Fundus photo · 1659 by 2212 pixels
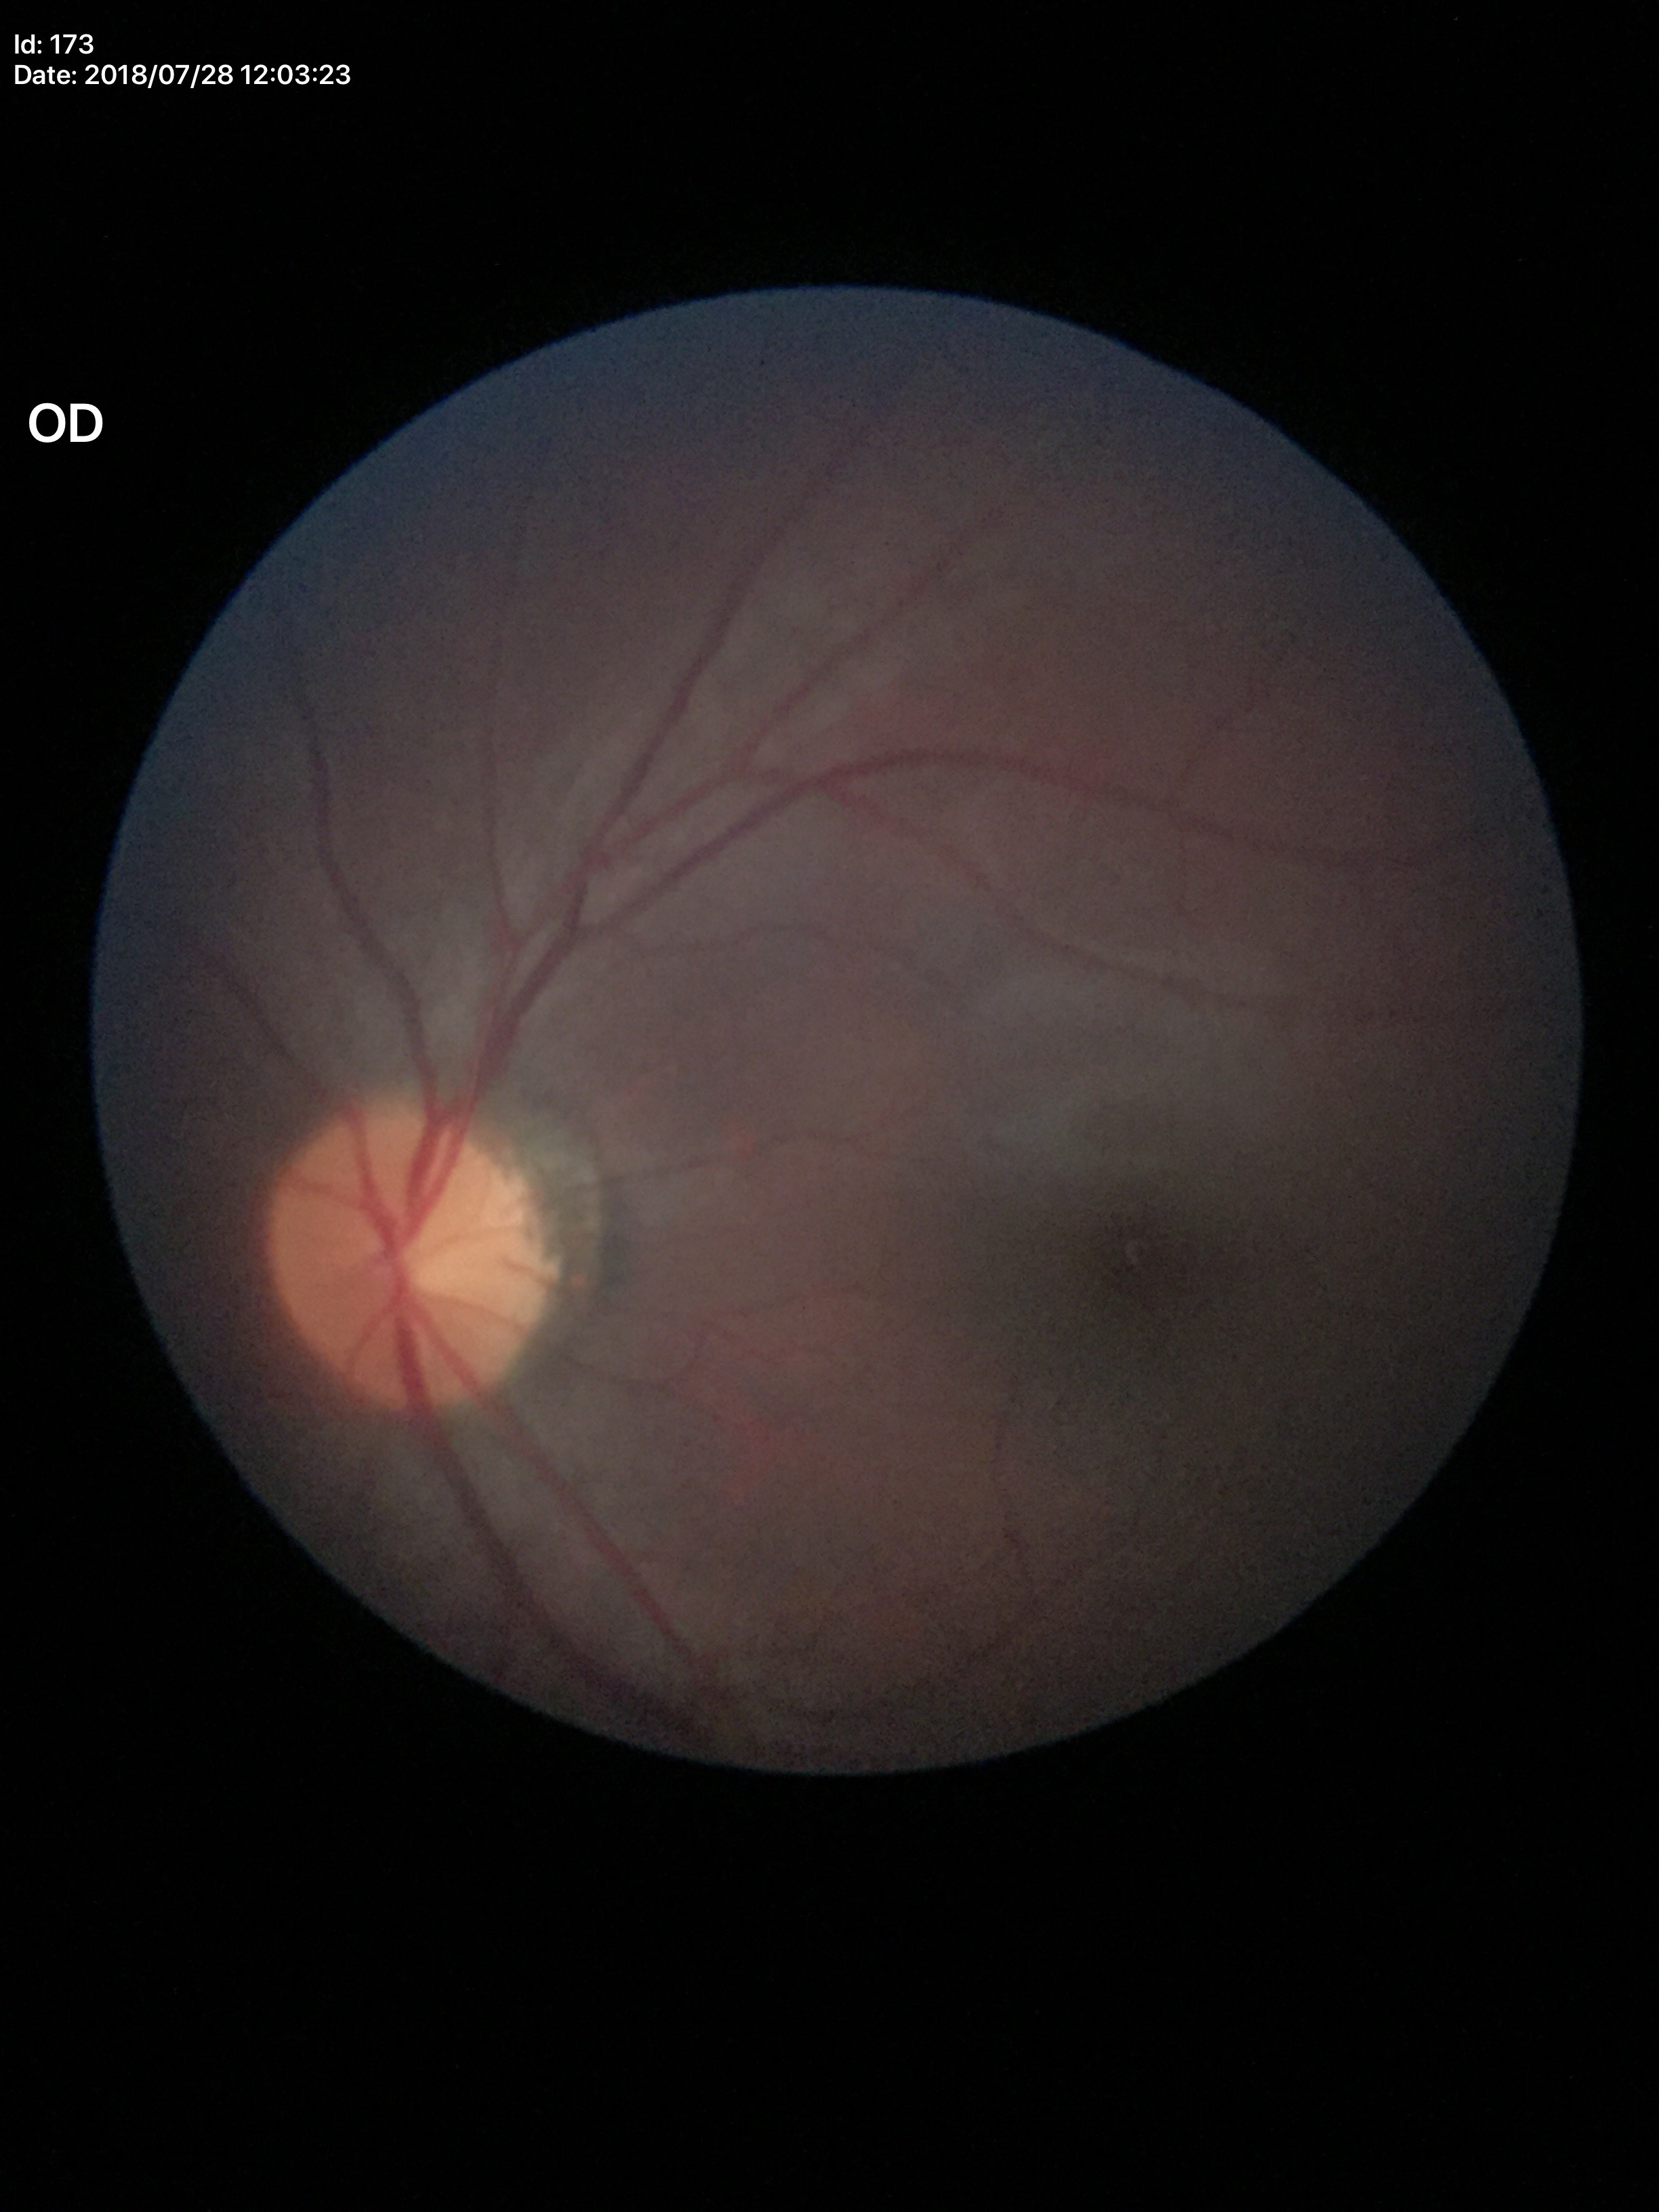 Glaucoma evaluation: not suspect (all 5 graders called normal) | VCDR: 0.43